Graded on the modified Davis scale.
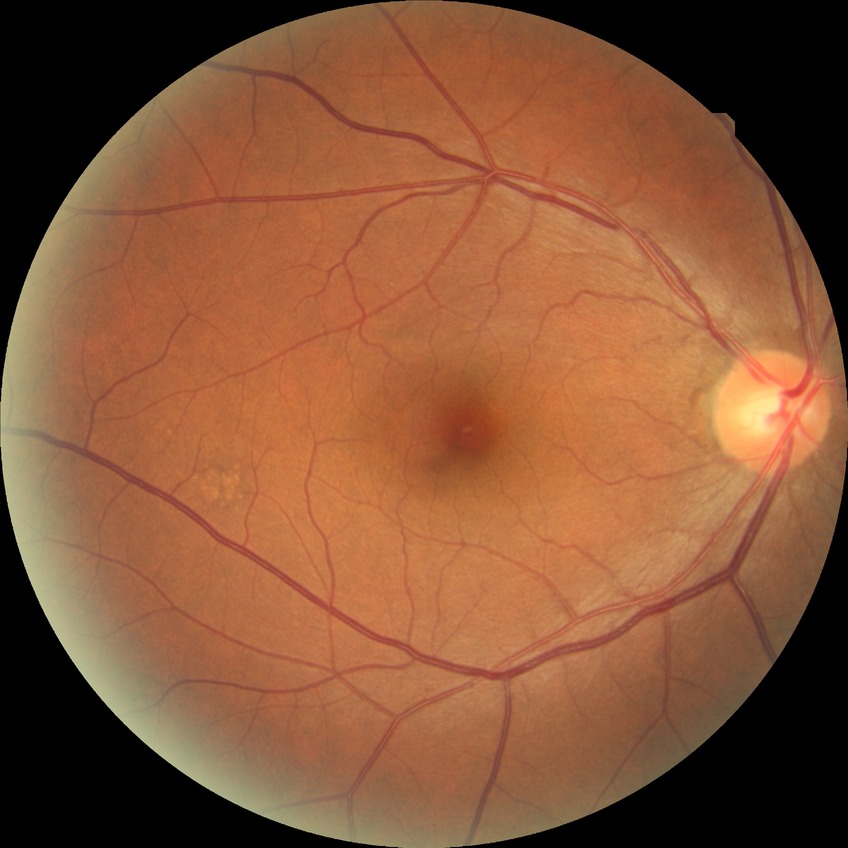
retinopathy grade=no diabetic retinopathy.